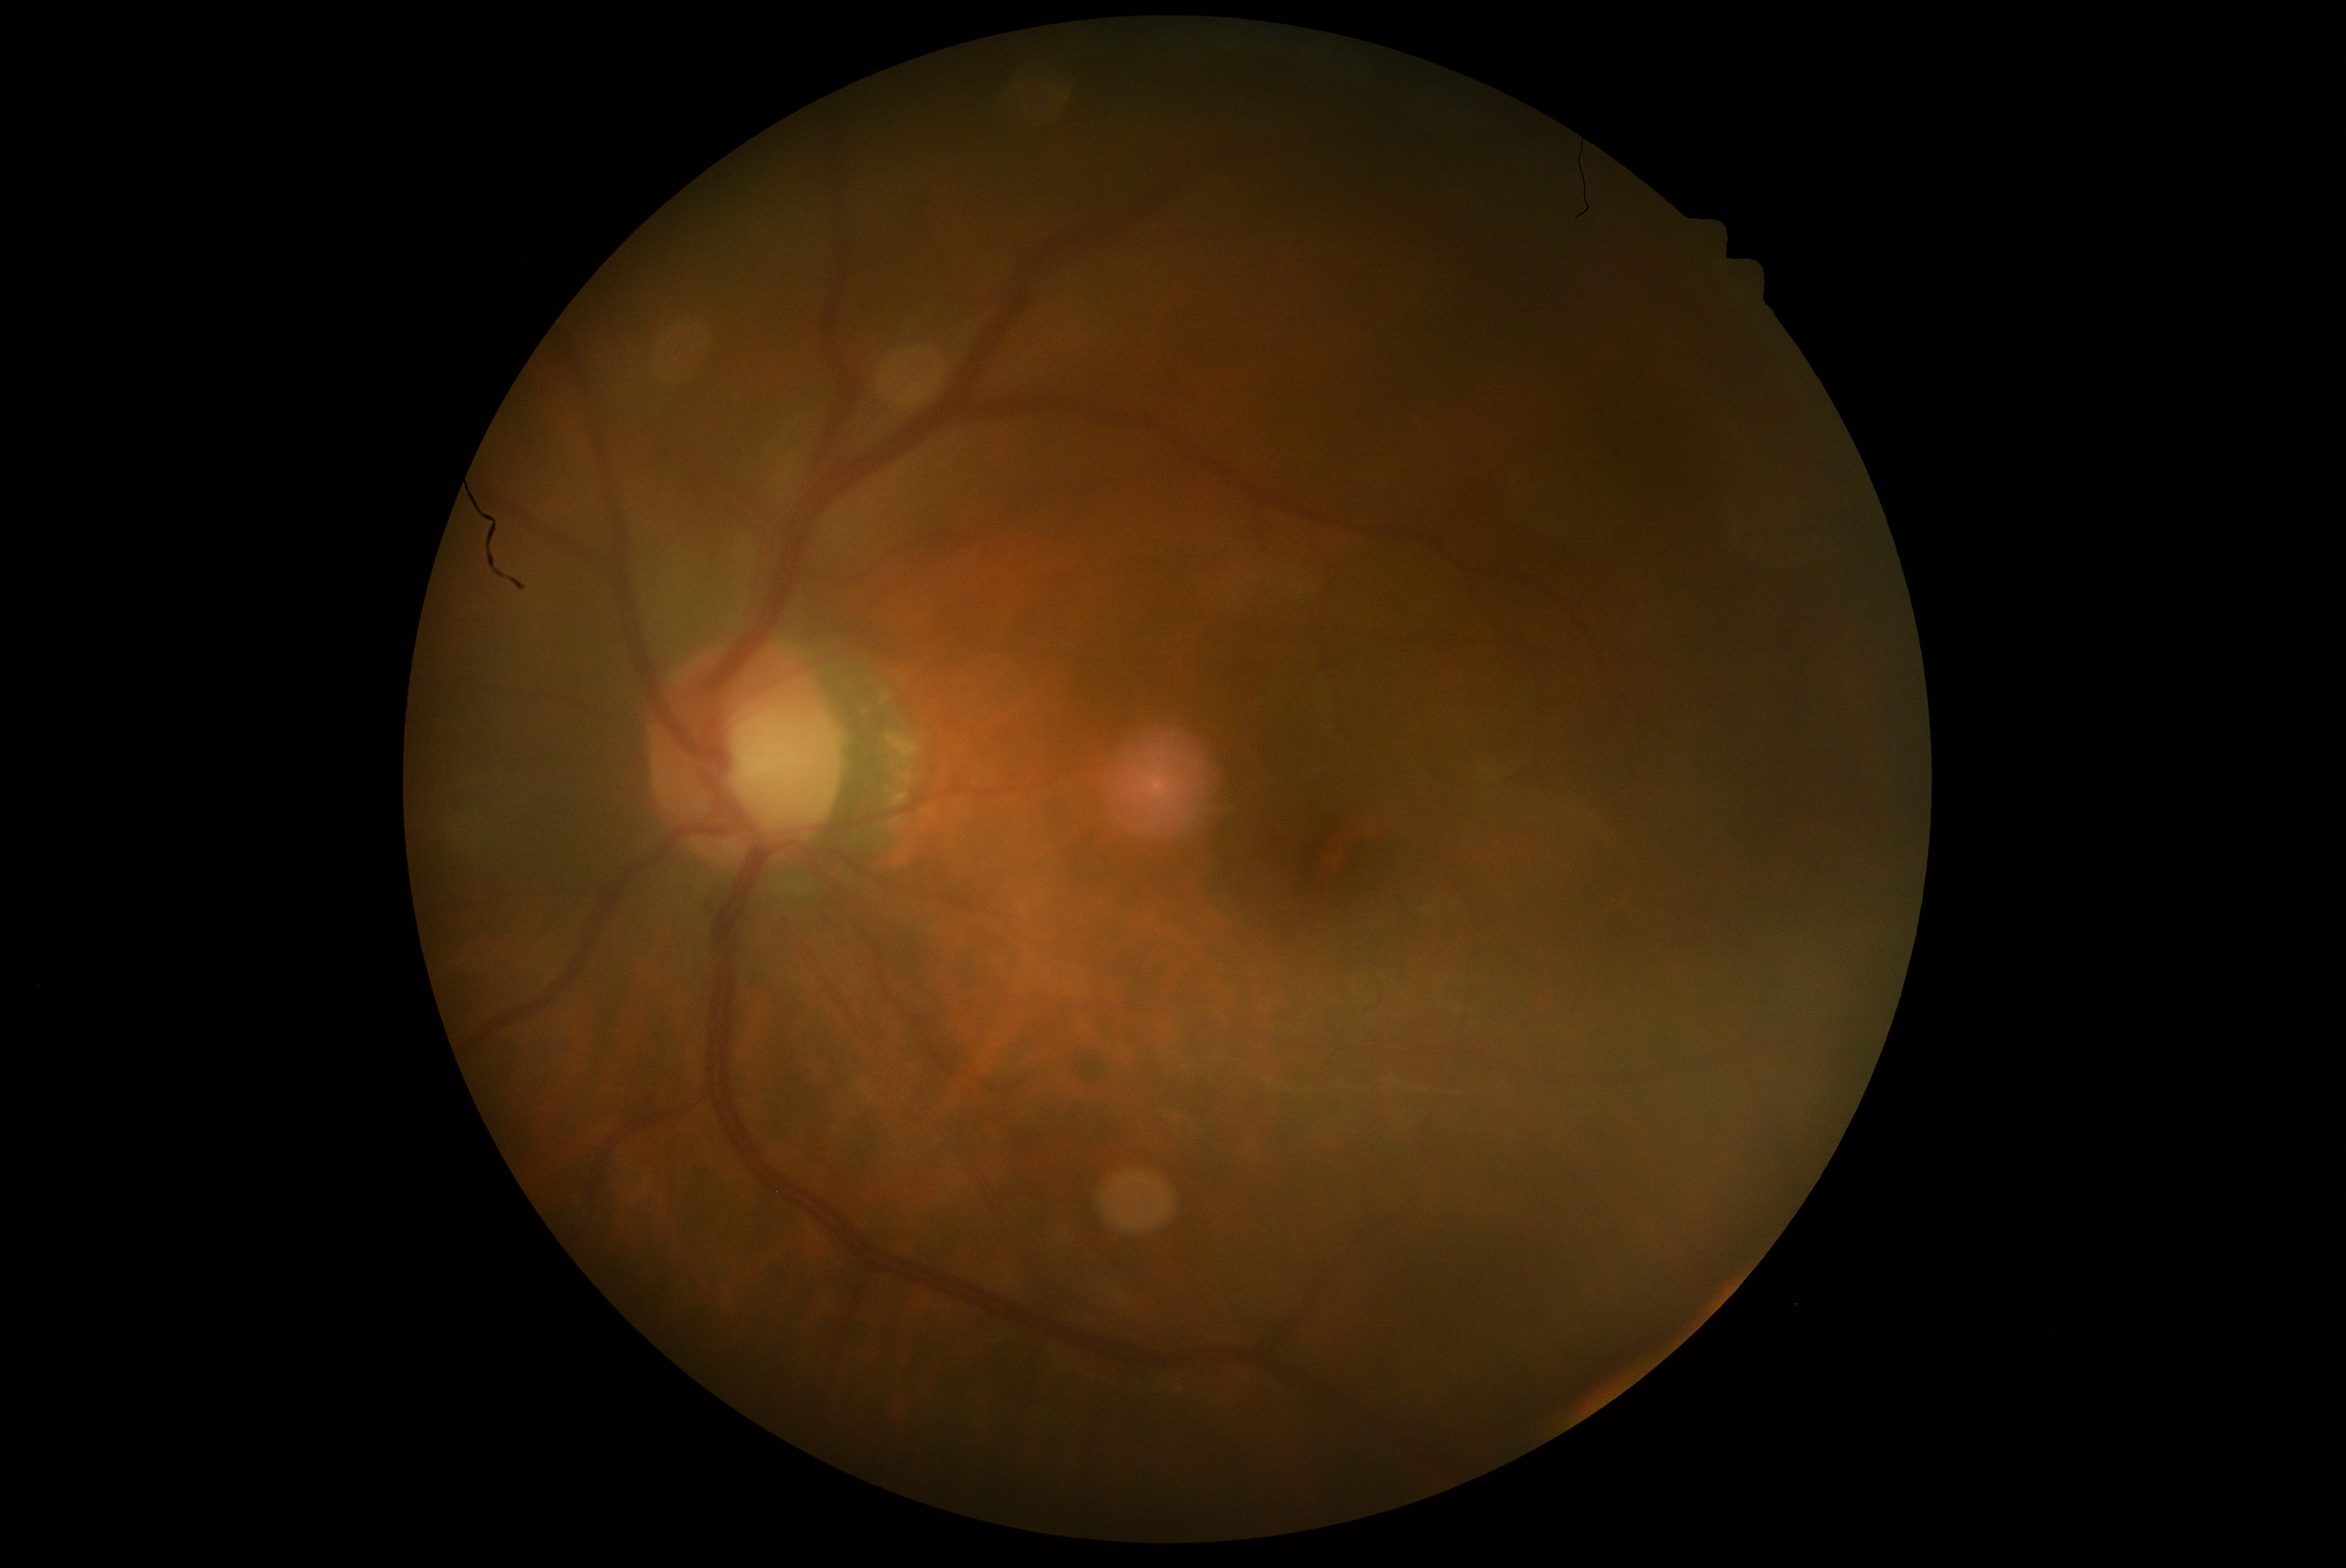 Annotations:
• DR impression: no DR findings
• diabetic retinopathy (DR): no apparent diabetic retinopathy (grade 0)